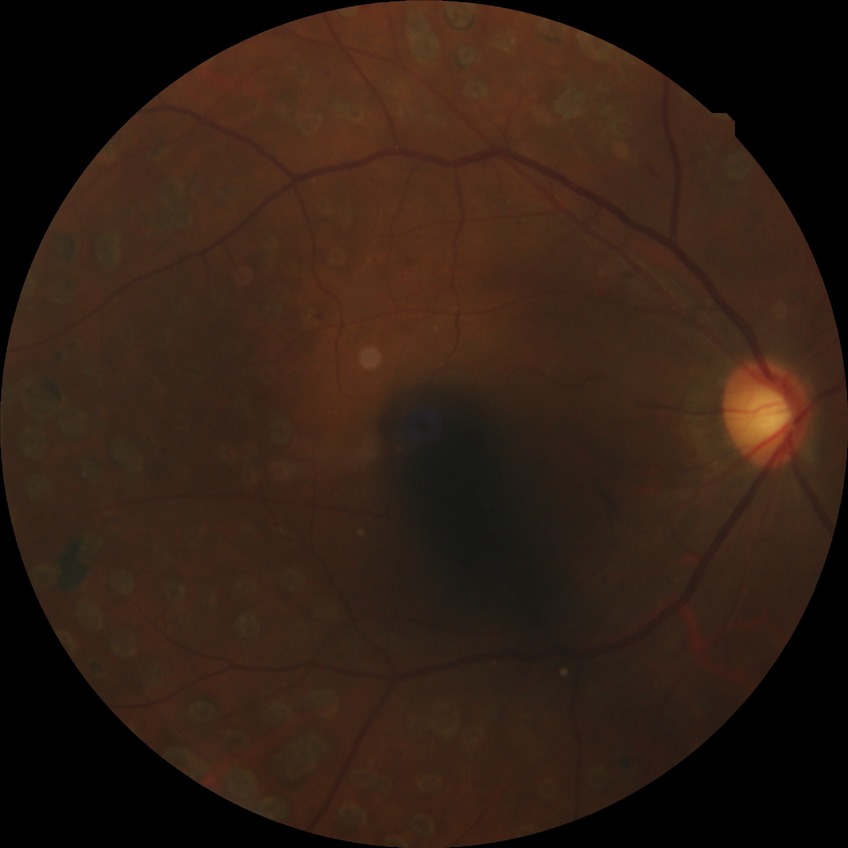
  davis_grade: proliferative diabetic retinopathy